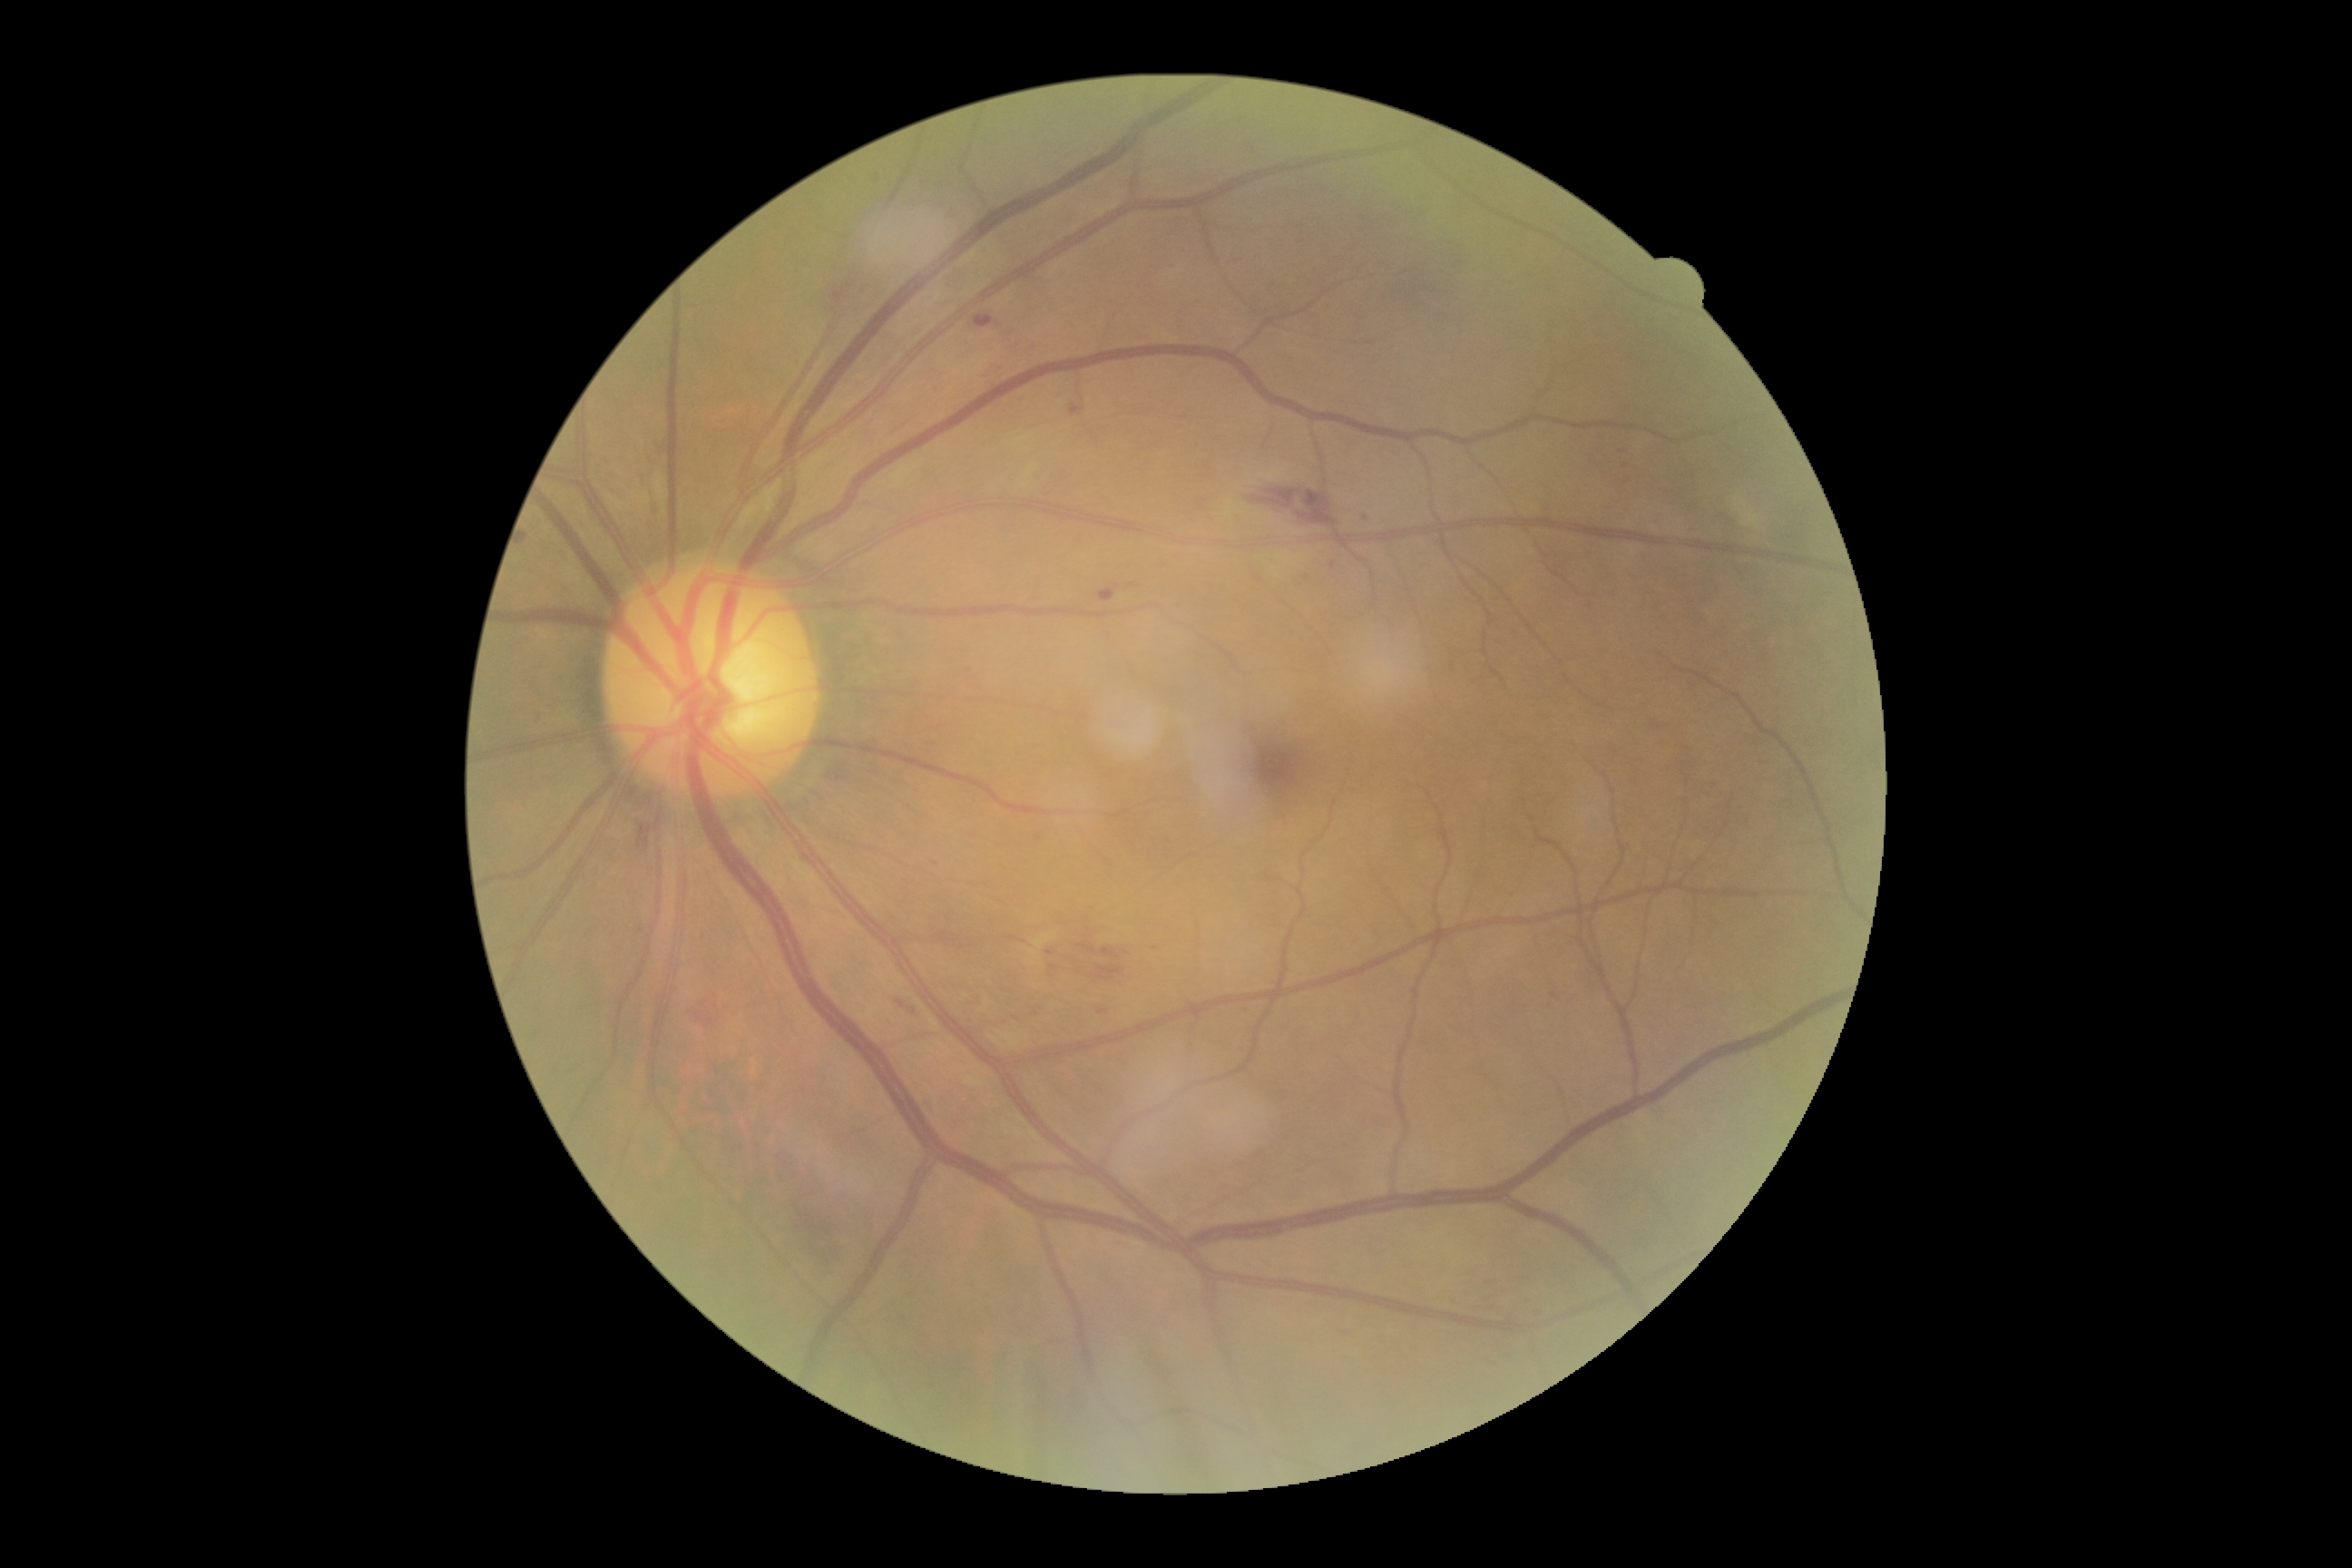
DR severity: grade 2 (moderate NPDR), DR class: non-proliferative diabetic retinopathy.